45-degree field of view. Color fundus image. 2352 by 1568 pixels — 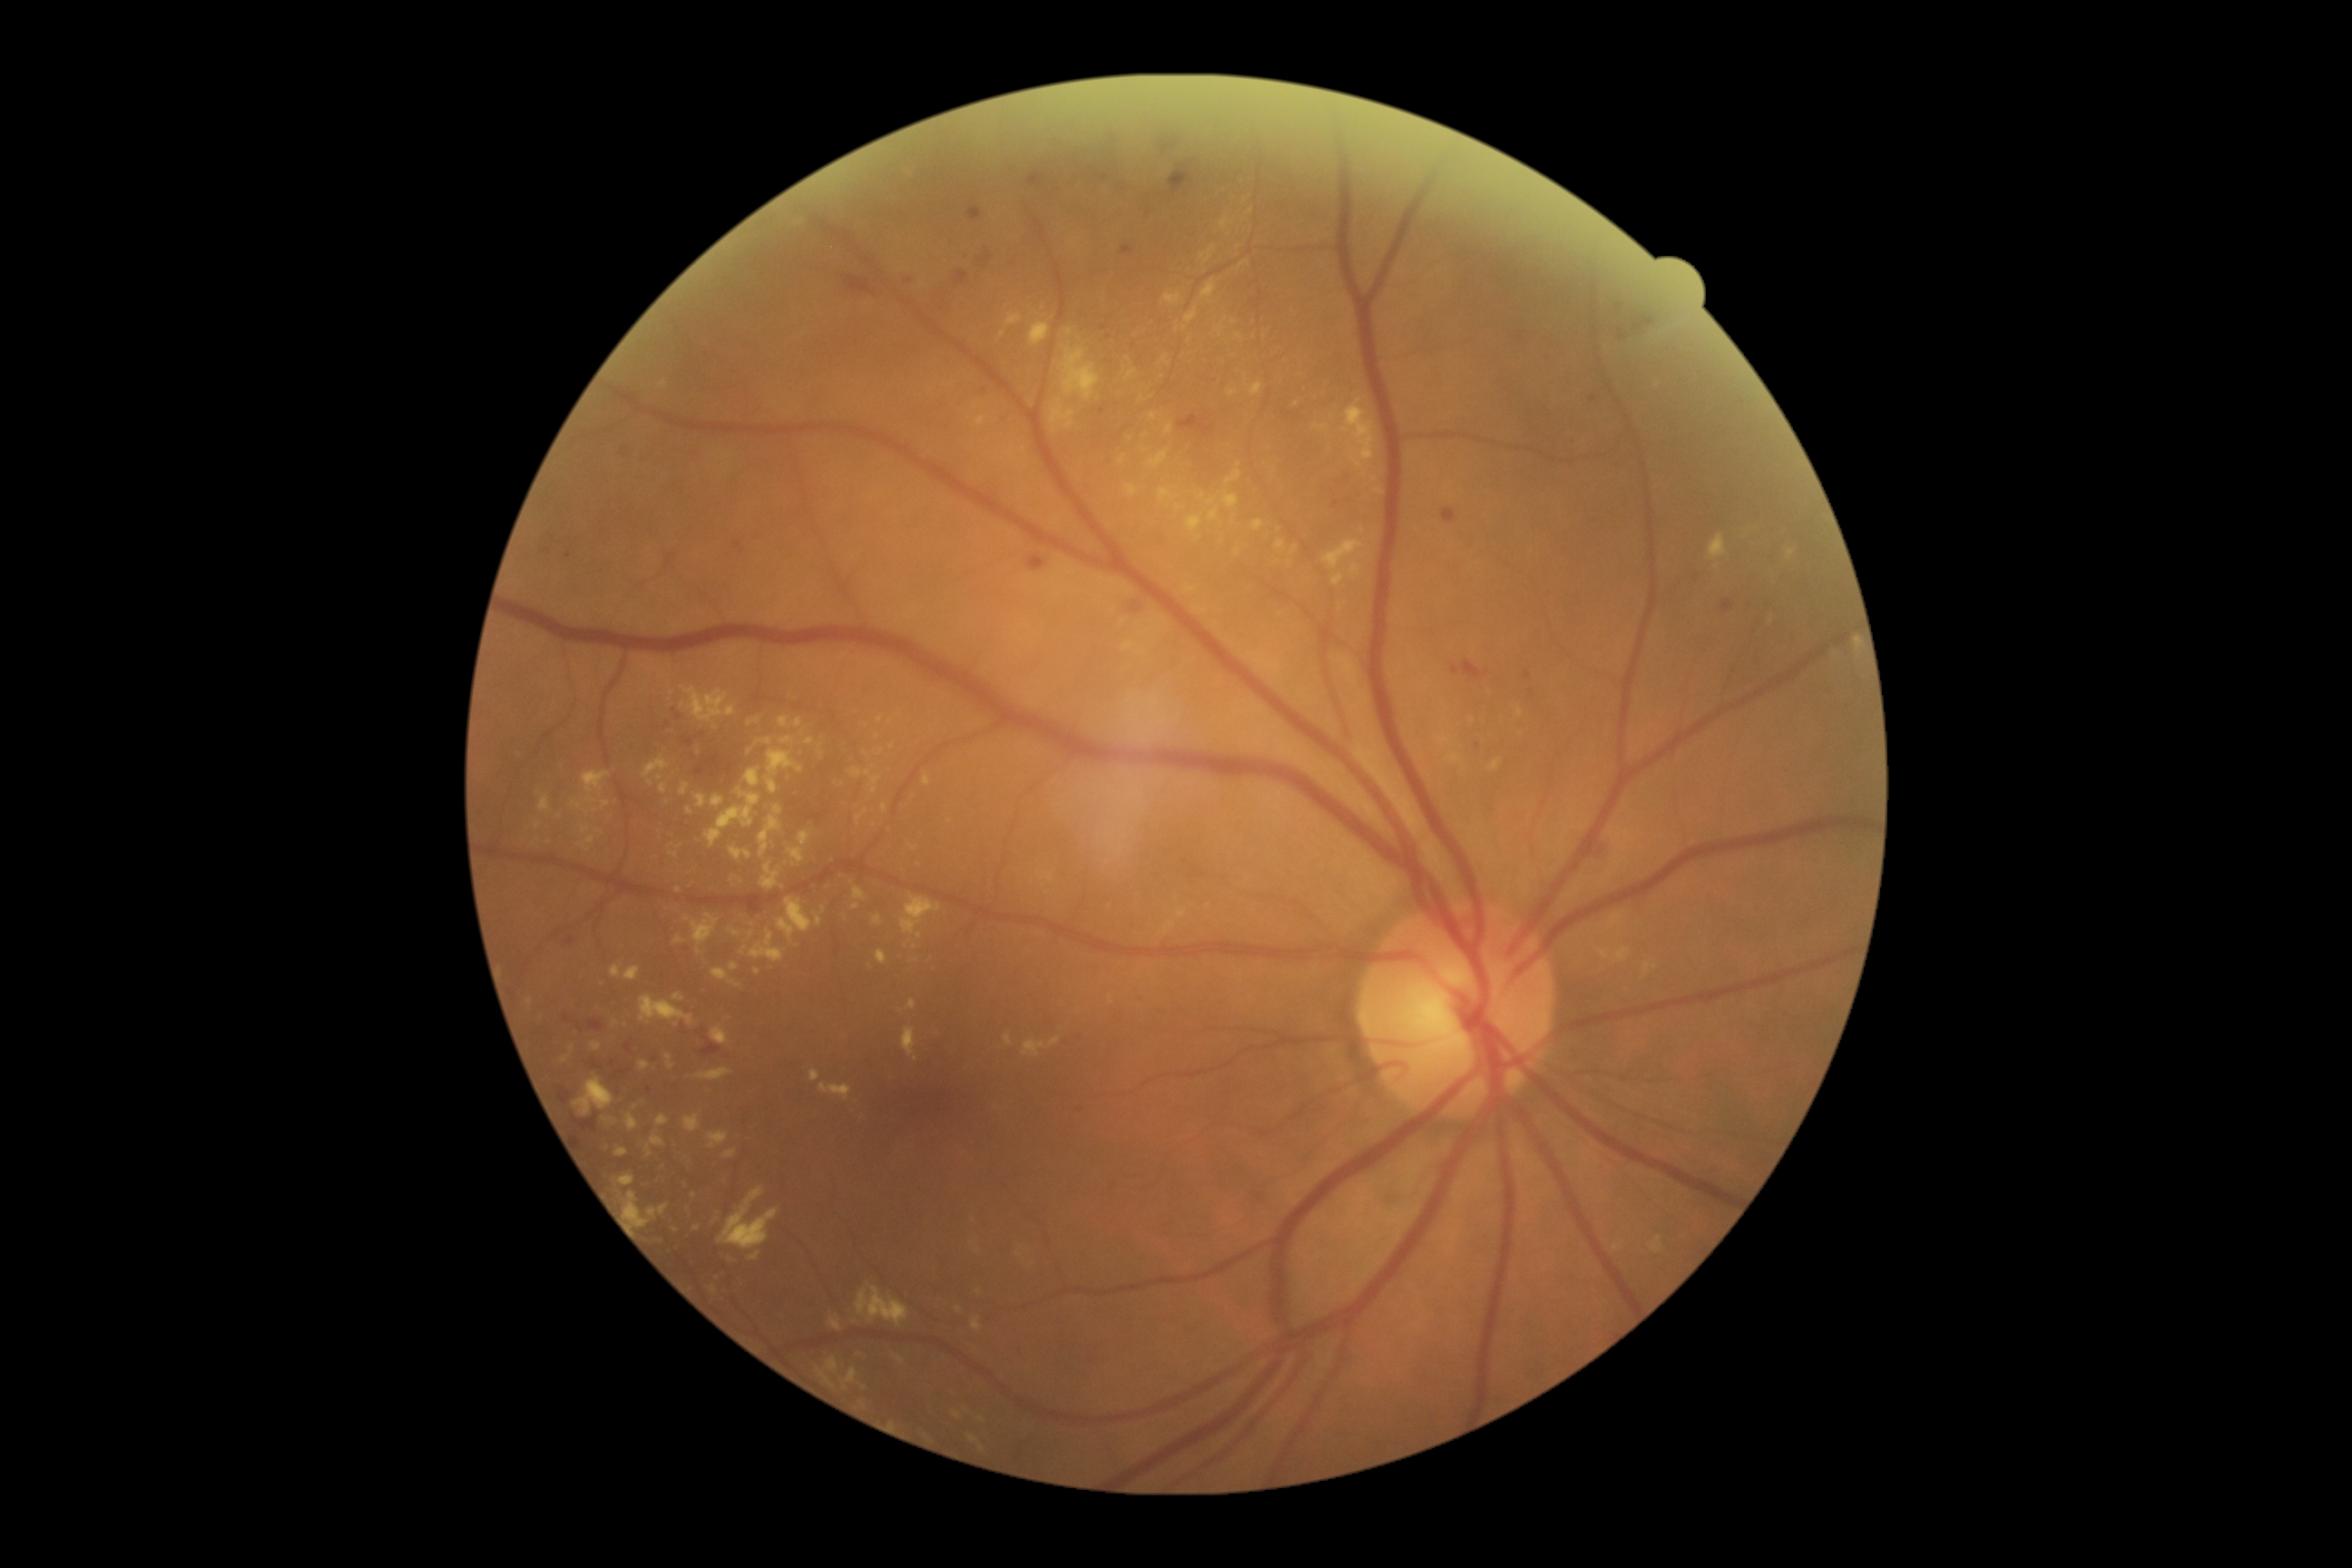 Diabetic retinopathy grade: 2 (moderate NPDR). Hard exudates (partial list) at {"x1": 750, "y1": 1251, "x2": 761, "y2": 1262}, {"x1": 602, "y1": 1117, "x2": 618, "y2": 1126}, {"x1": 562, "y1": 1057, "x2": 571, "y2": 1064}, {"x1": 709, "y1": 1286, "x2": 718, "y2": 1295}, {"x1": 903, "y1": 1028, "x2": 917, "y2": 1057}, {"x1": 687, "y1": 808, "x2": 694, "y2": 816}, {"x1": 1186, "y1": 306, "x2": 1199, "y2": 326}, {"x1": 858, "y1": 1284, "x2": 910, "y2": 1328}, {"x1": 760, "y1": 816, "x2": 781, "y2": 858}, {"x1": 850, "y1": 769, "x2": 870, "y2": 778}, {"x1": 874, "y1": 916, "x2": 883, "y2": 926}, {"x1": 798, "y1": 830, "x2": 810, "y2": 847}. Hard exudates (small, approximate centers) near (573, 1049), (978, 1252), (1347, 317), (635, 1108), (698, 752), (877, 738), (1473, 721).